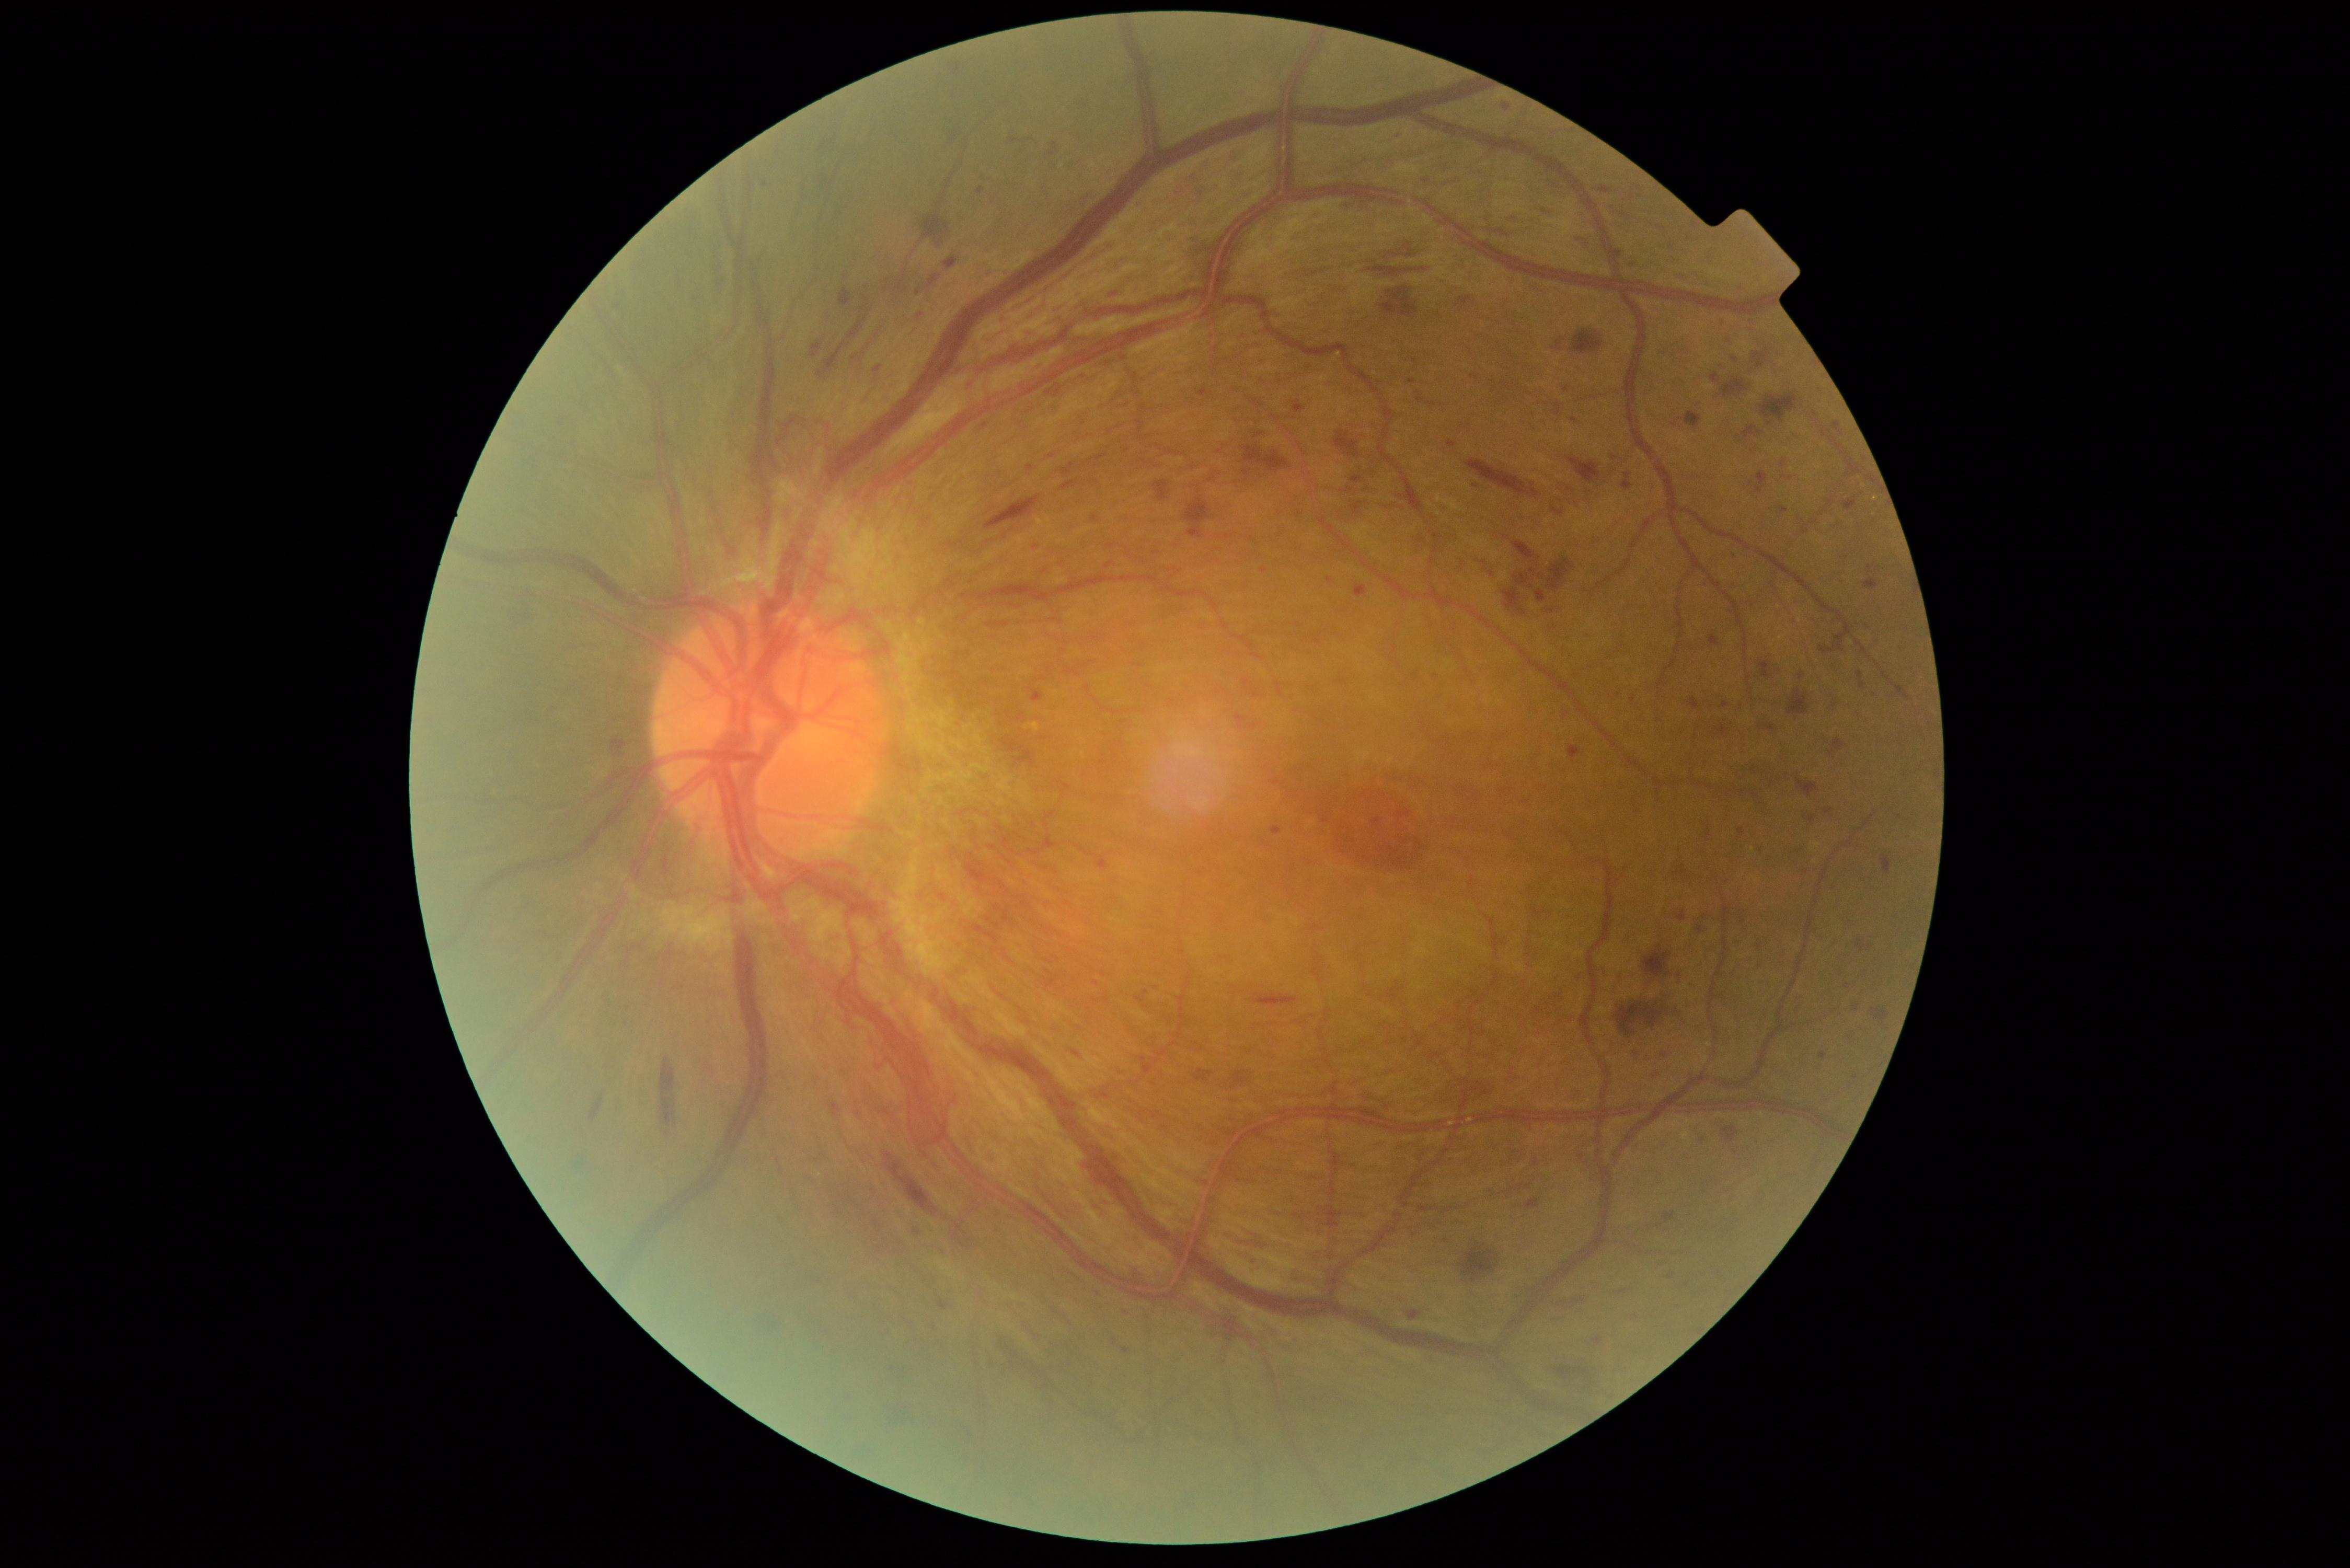

partial: true
dr_grade: 4
dr_grade_name: PDR
lesions:
  he:
    - 1864/579/1878/590
    - 777/437/786/448
    - 1243/446/1292/472
    - 1185/497/1210/524
    - 1540/206/1554/222
    - 1787/690/1809/714
    - 1756/472/1768/494
    - 1725/1126/1739/1141
    - 924/214/951/247
    - 1189/528/1204/540
    - 1556/403/1561/417
    - 1228/149/1241/159
    - 1195/1069/1213/1082
    - 985/496/1041/531
    - 1049/143/1058/156
    - 944/257/958/270
    - 1090/851/1110/869
    - 1721/379/1747/397
    - 1073/1051/1081/1057
  he_small_centers:
    - (1671,1277)
  ma:
    - 1409/1311/1422/1320
    - 1844/499/1857/511
    - 1190/528/1200/537
    - 1563/386/1571/393
    - 1569/749/1577/760
    - 977/187/985/194
  ma_small_centers:
    - (1633,265)
    - (1723,323)
    - (1855,1077)
    - (1036,547)
    - (1753,770)
    - (879,369)
    - (1633,700)
    - (1812,819)
    - (1329,582)
    - (1761,851)